Infant wide-field fundus photograph. 1240x1240px: 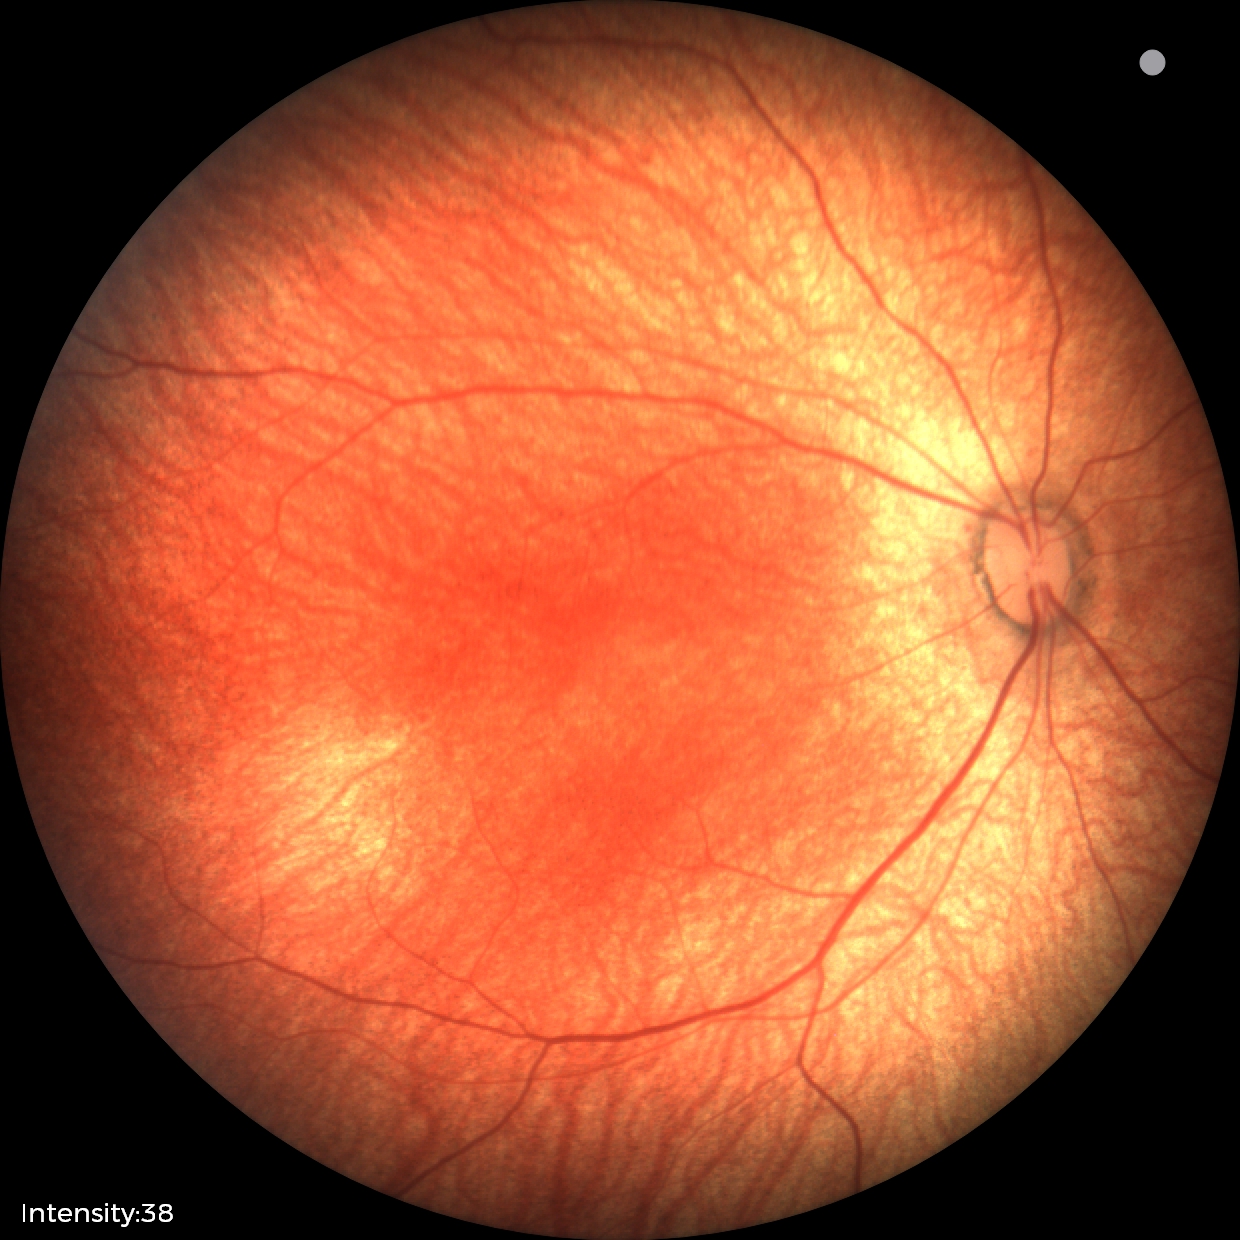 Normal screening examination.